2048x1536 — 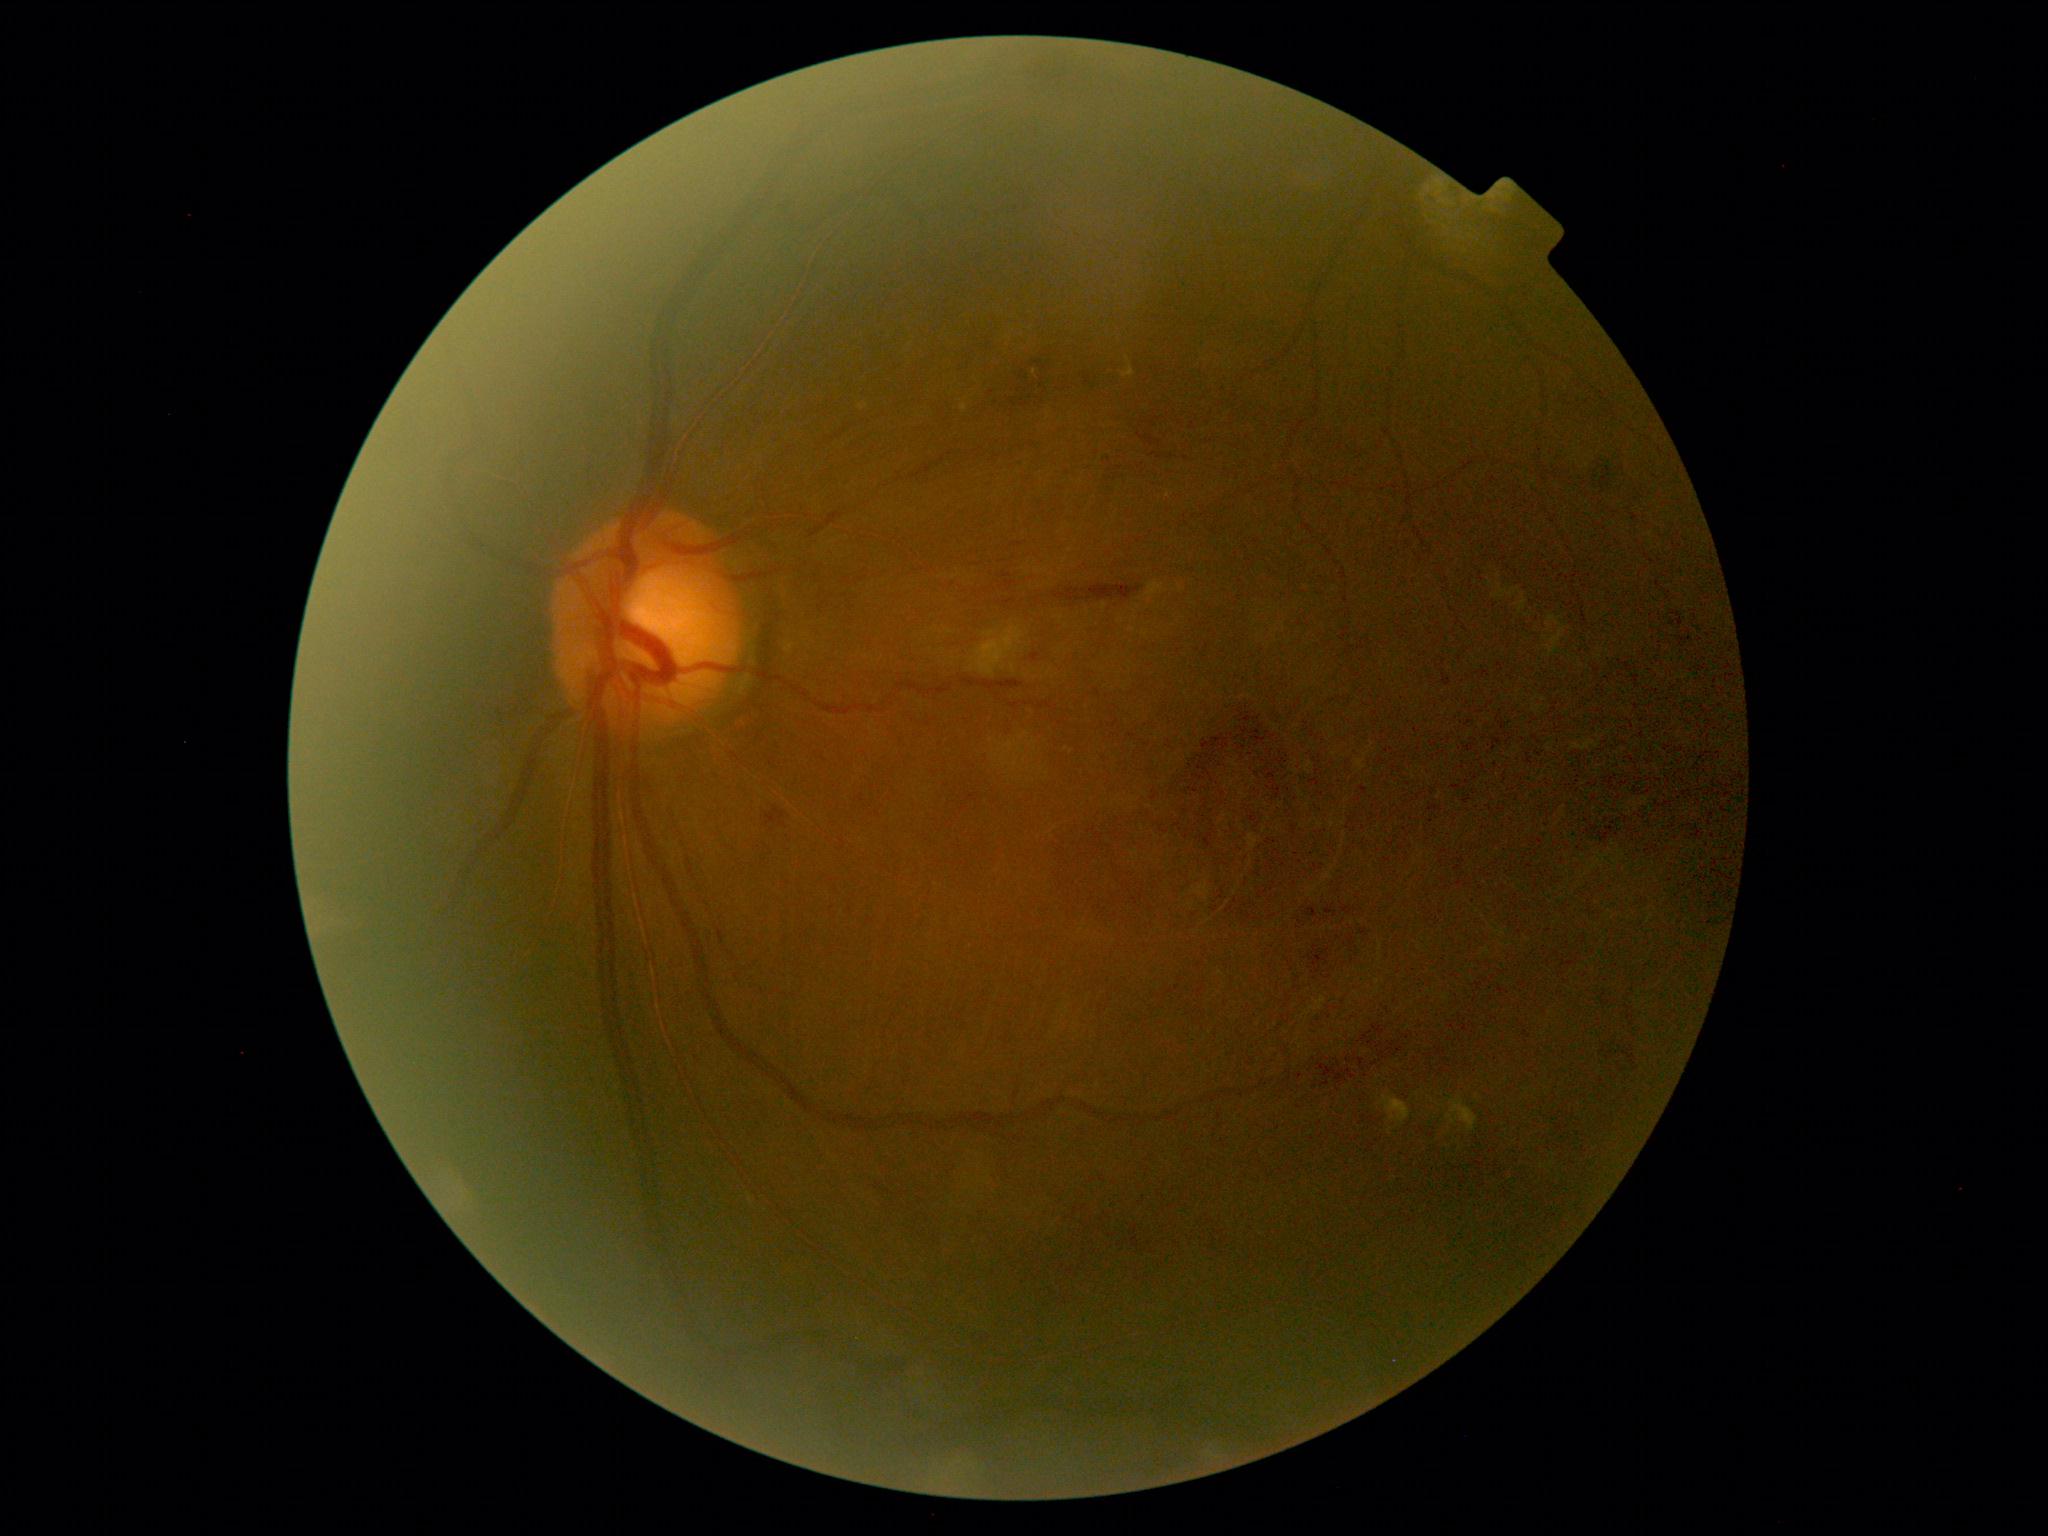
{"dr_grade": "moderate NPDR (grade 2)"}